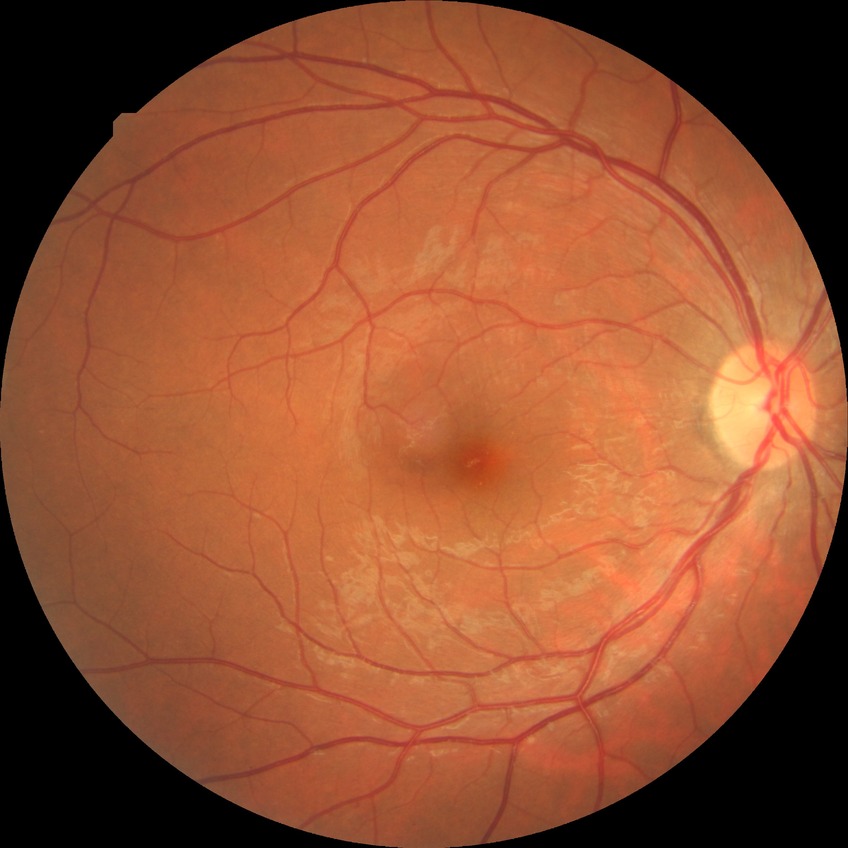

Diabetic retinopathy stage is no diabetic retinopathy.